Wide-field fundus photograph of an infant — 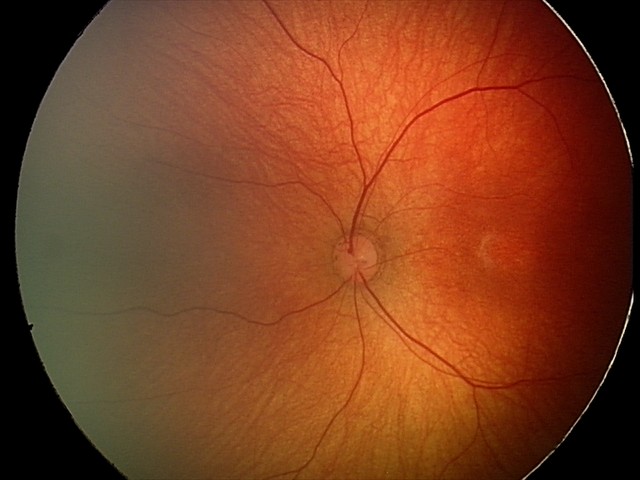

Diagnosis: no abnormalities